45° field of view
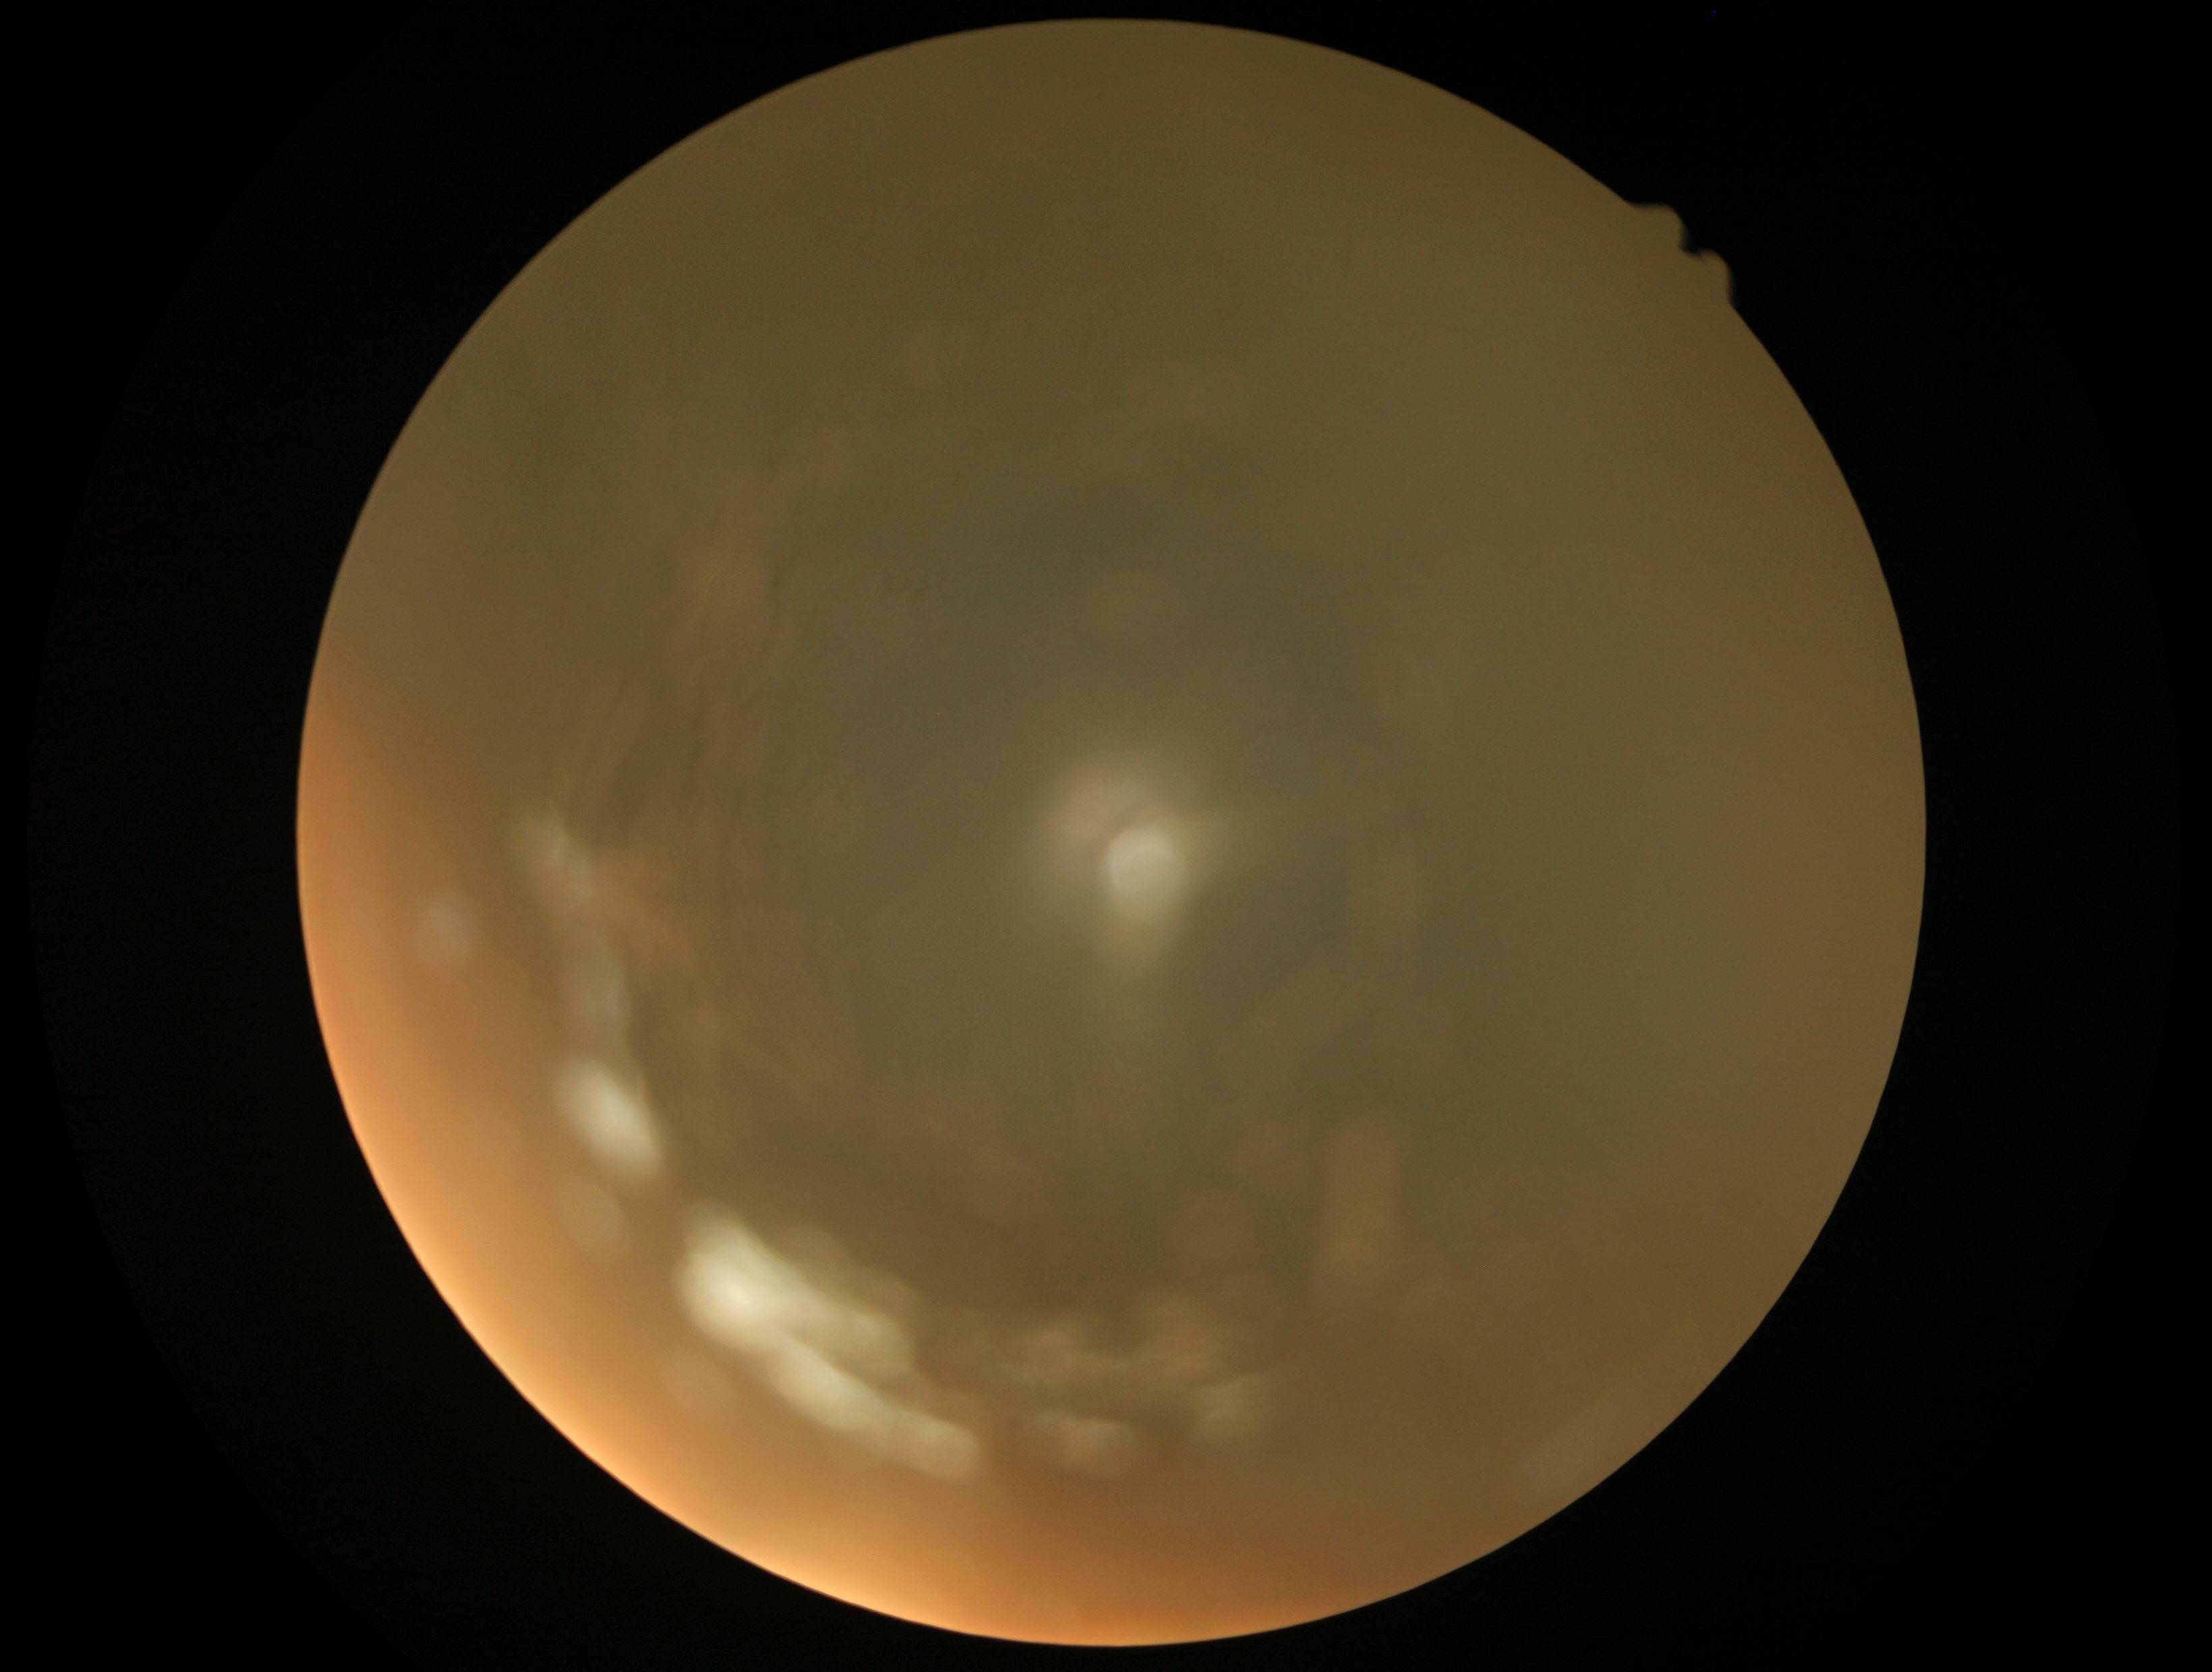

Quality too poor to assess for DR. Diabetic retinopathy (DR): ungradable.